Wide-field fundus photograph of an infant; 130° field of view (Clarity RetCam 3) — 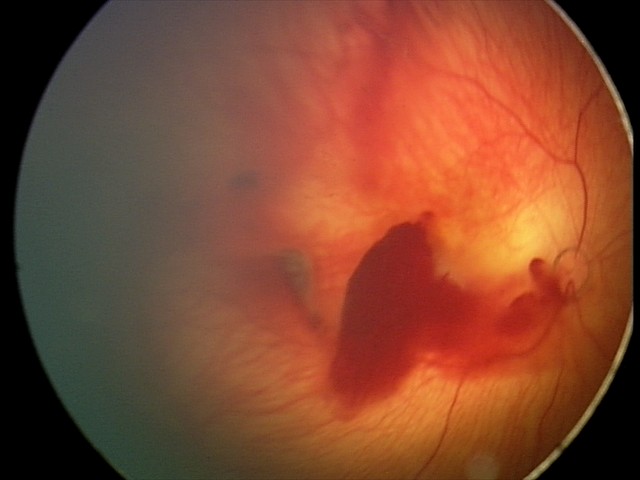

Screening series with retinal hemorrhages.